Camera: NIDEK AFC-230, 848x848px — 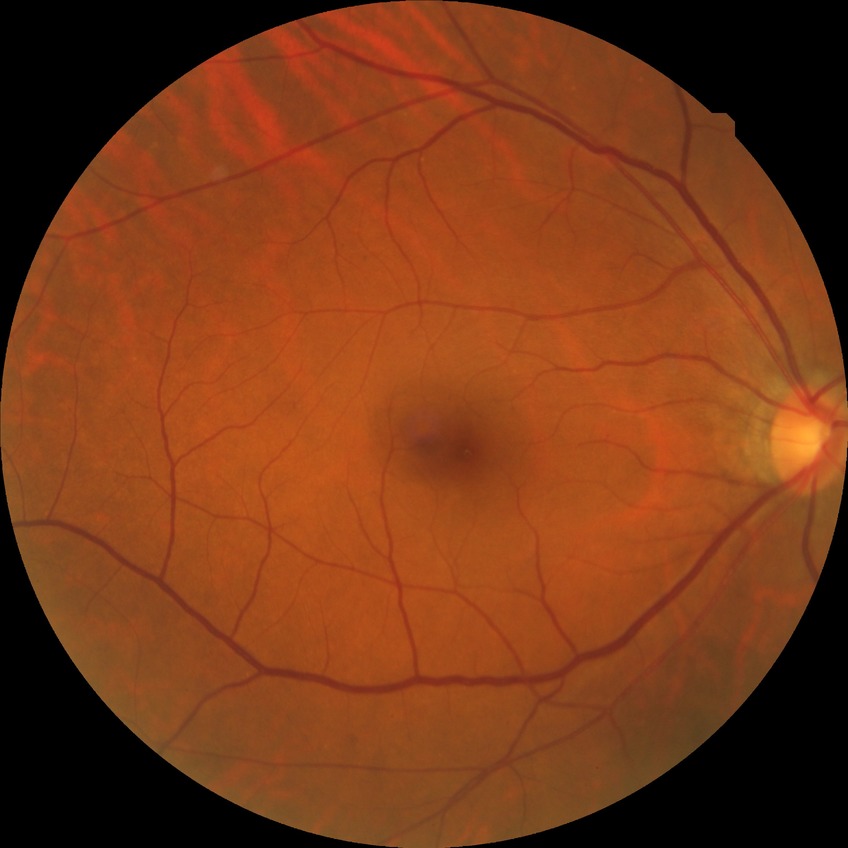
Diabetic retinopathy (DR) is no diabetic retinopathy (NDR).